Color fundus photograph — 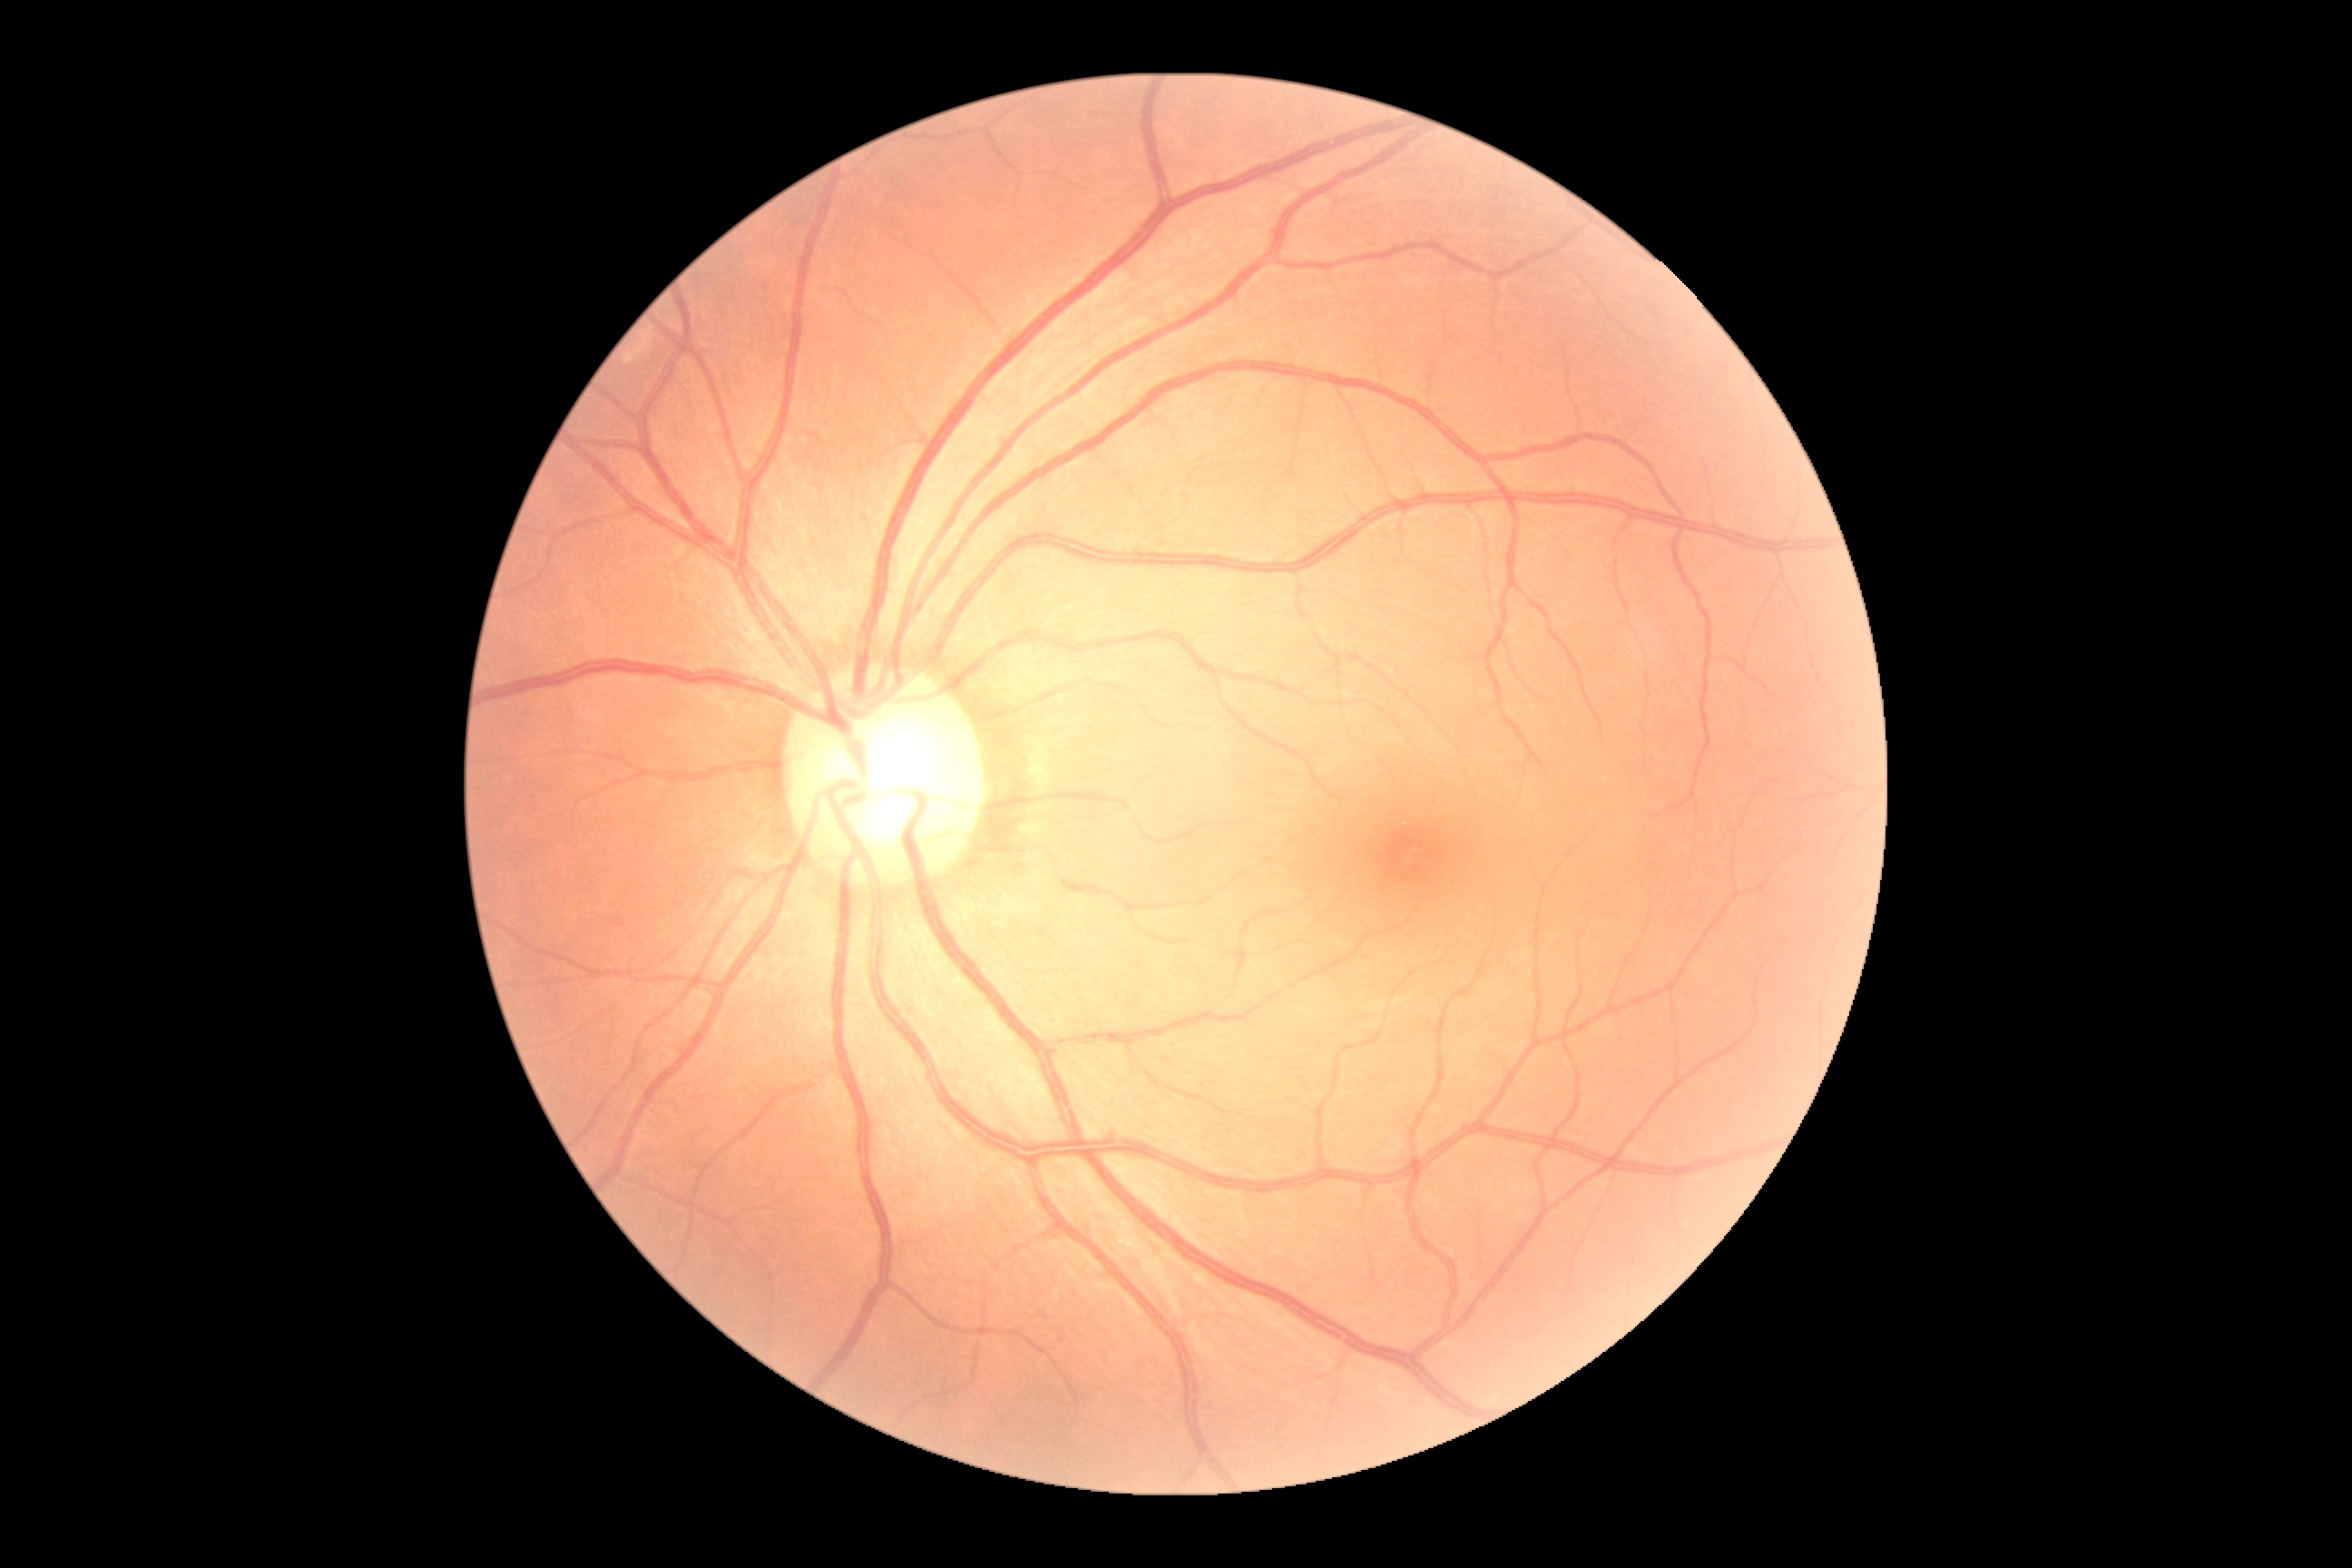
DR severity = no apparent retinopathy (grade 0).